Infant wide-field retinal image — 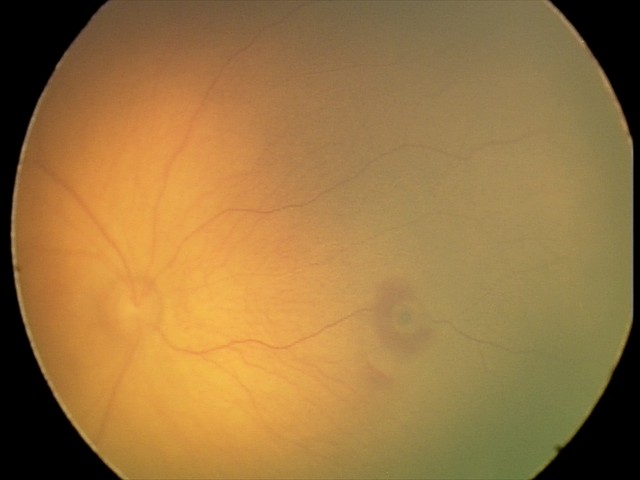

Assessment: retinal hemorrhages.